CFP; 45-degree field of view:
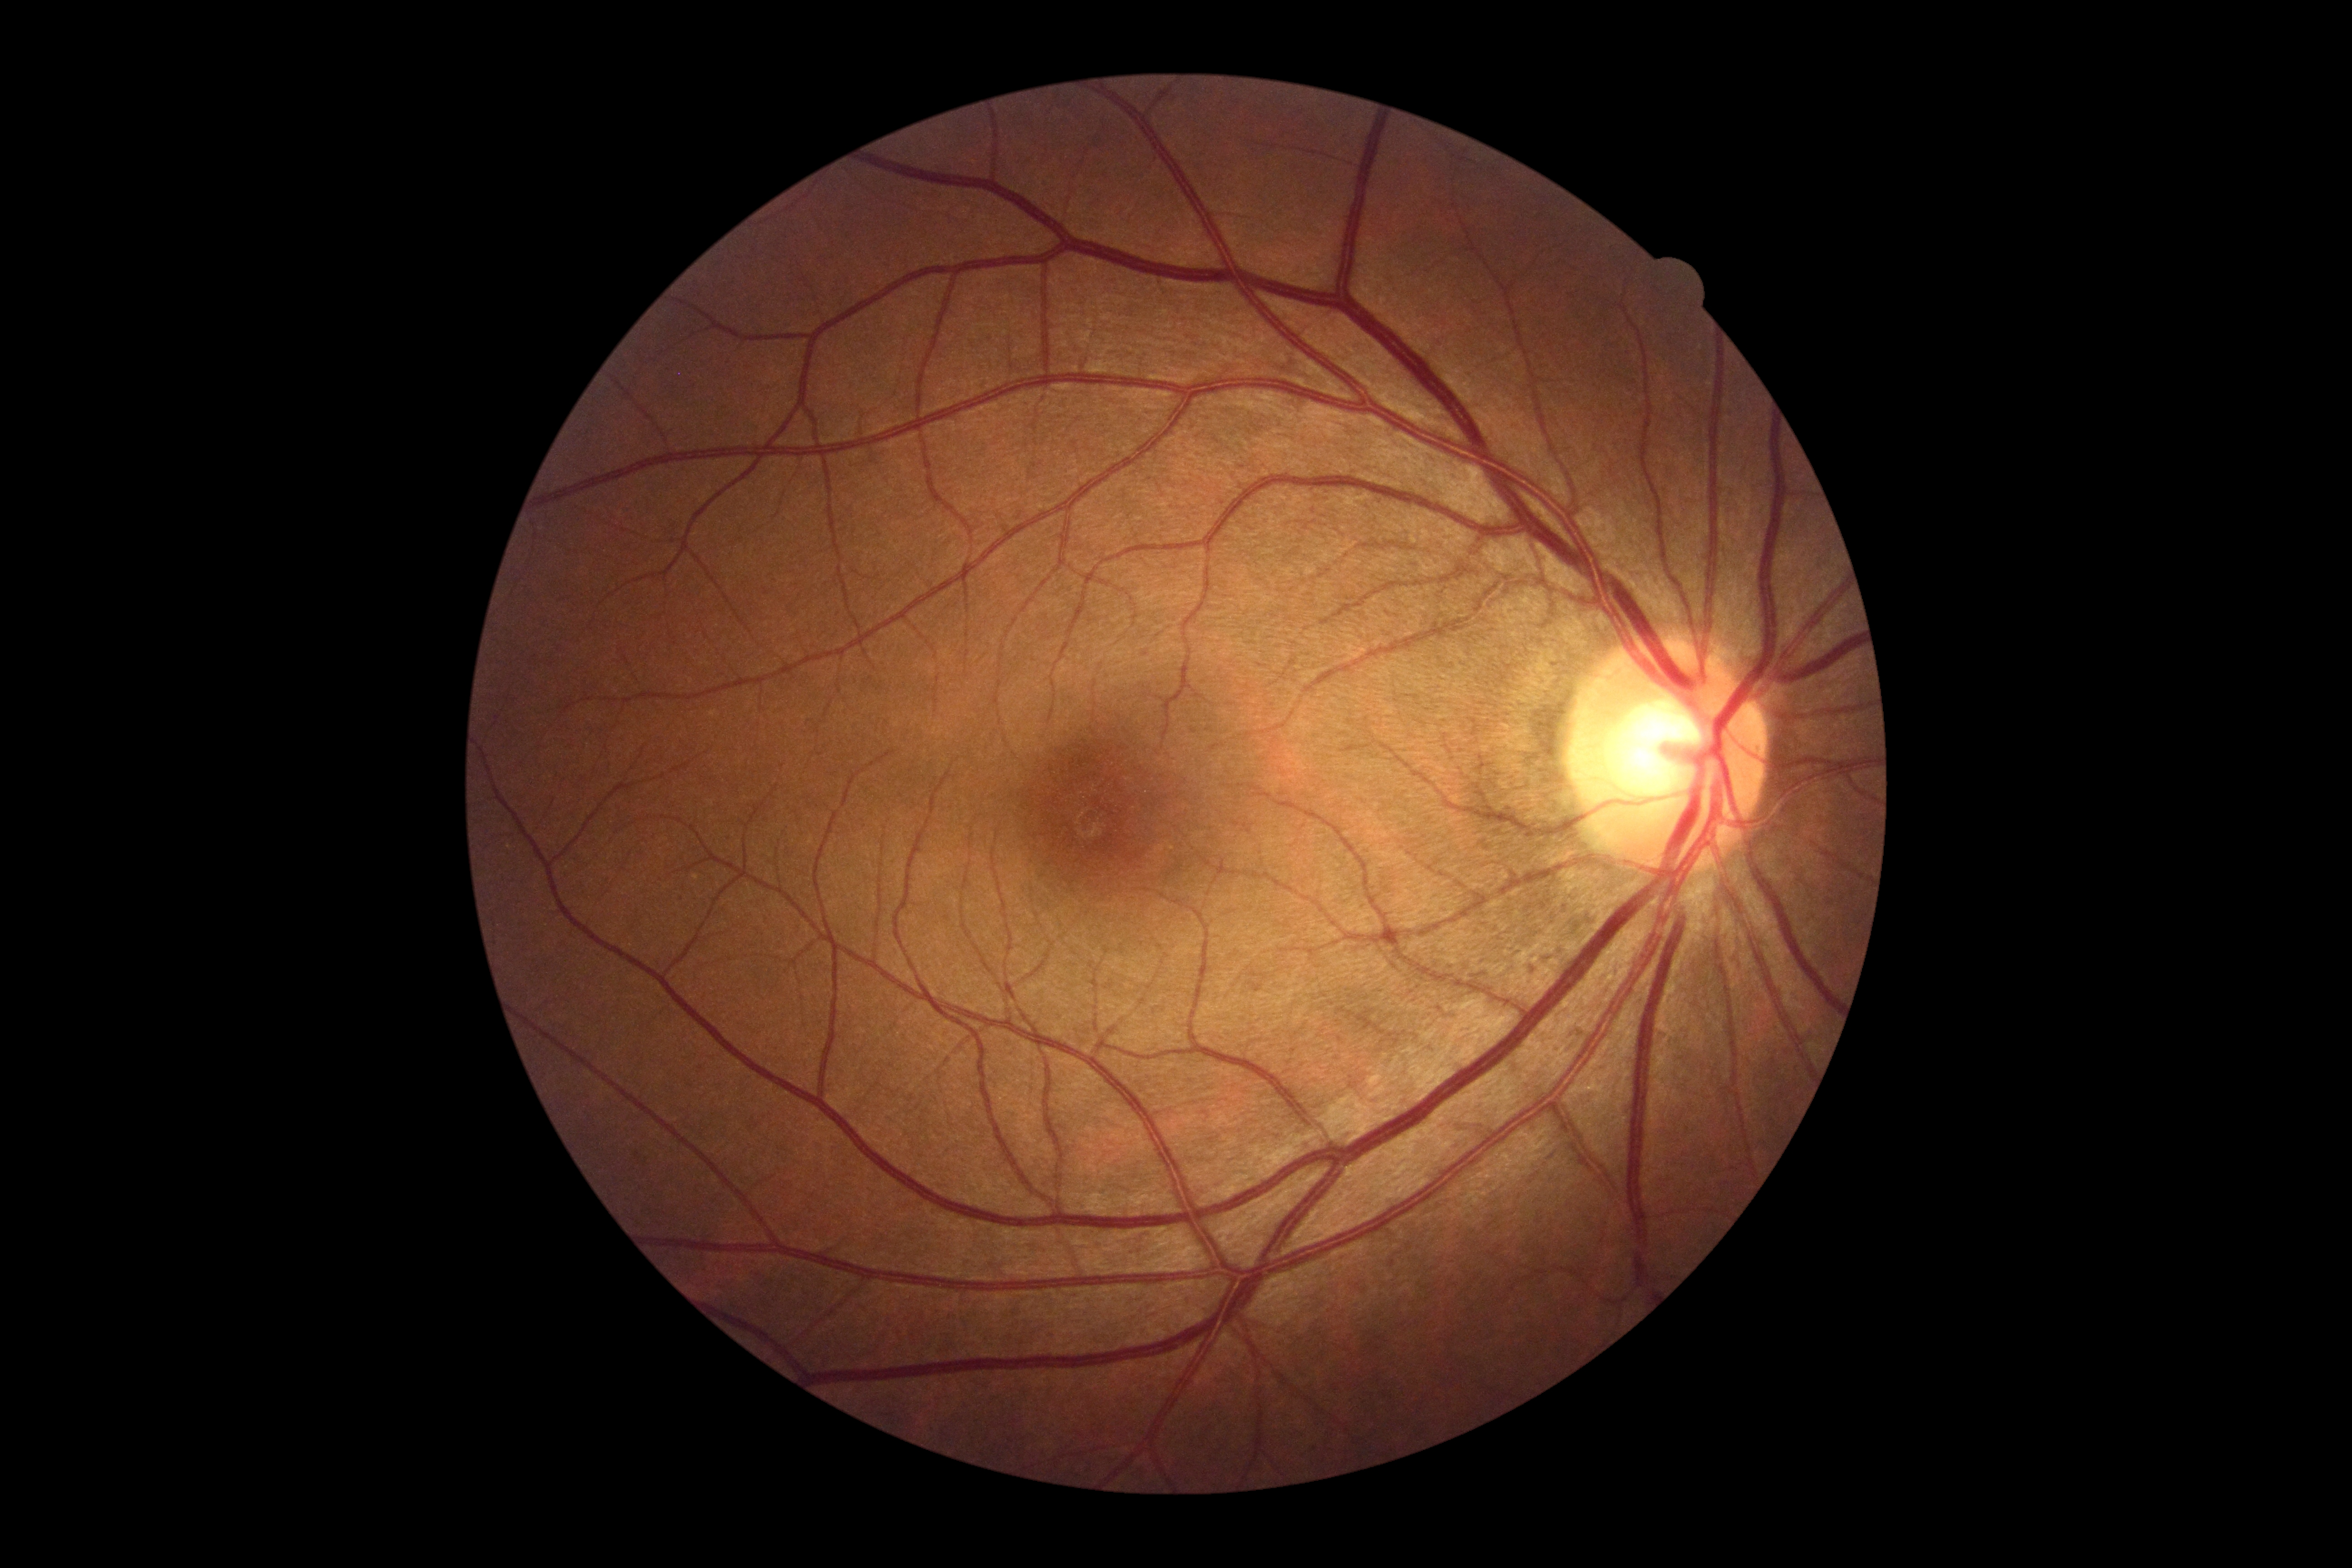

No DR findings. DR severity: grade 0 — no visible signs of diabetic retinopathy.